Mydriatic (tropicamide phenylephrine 1.0%): 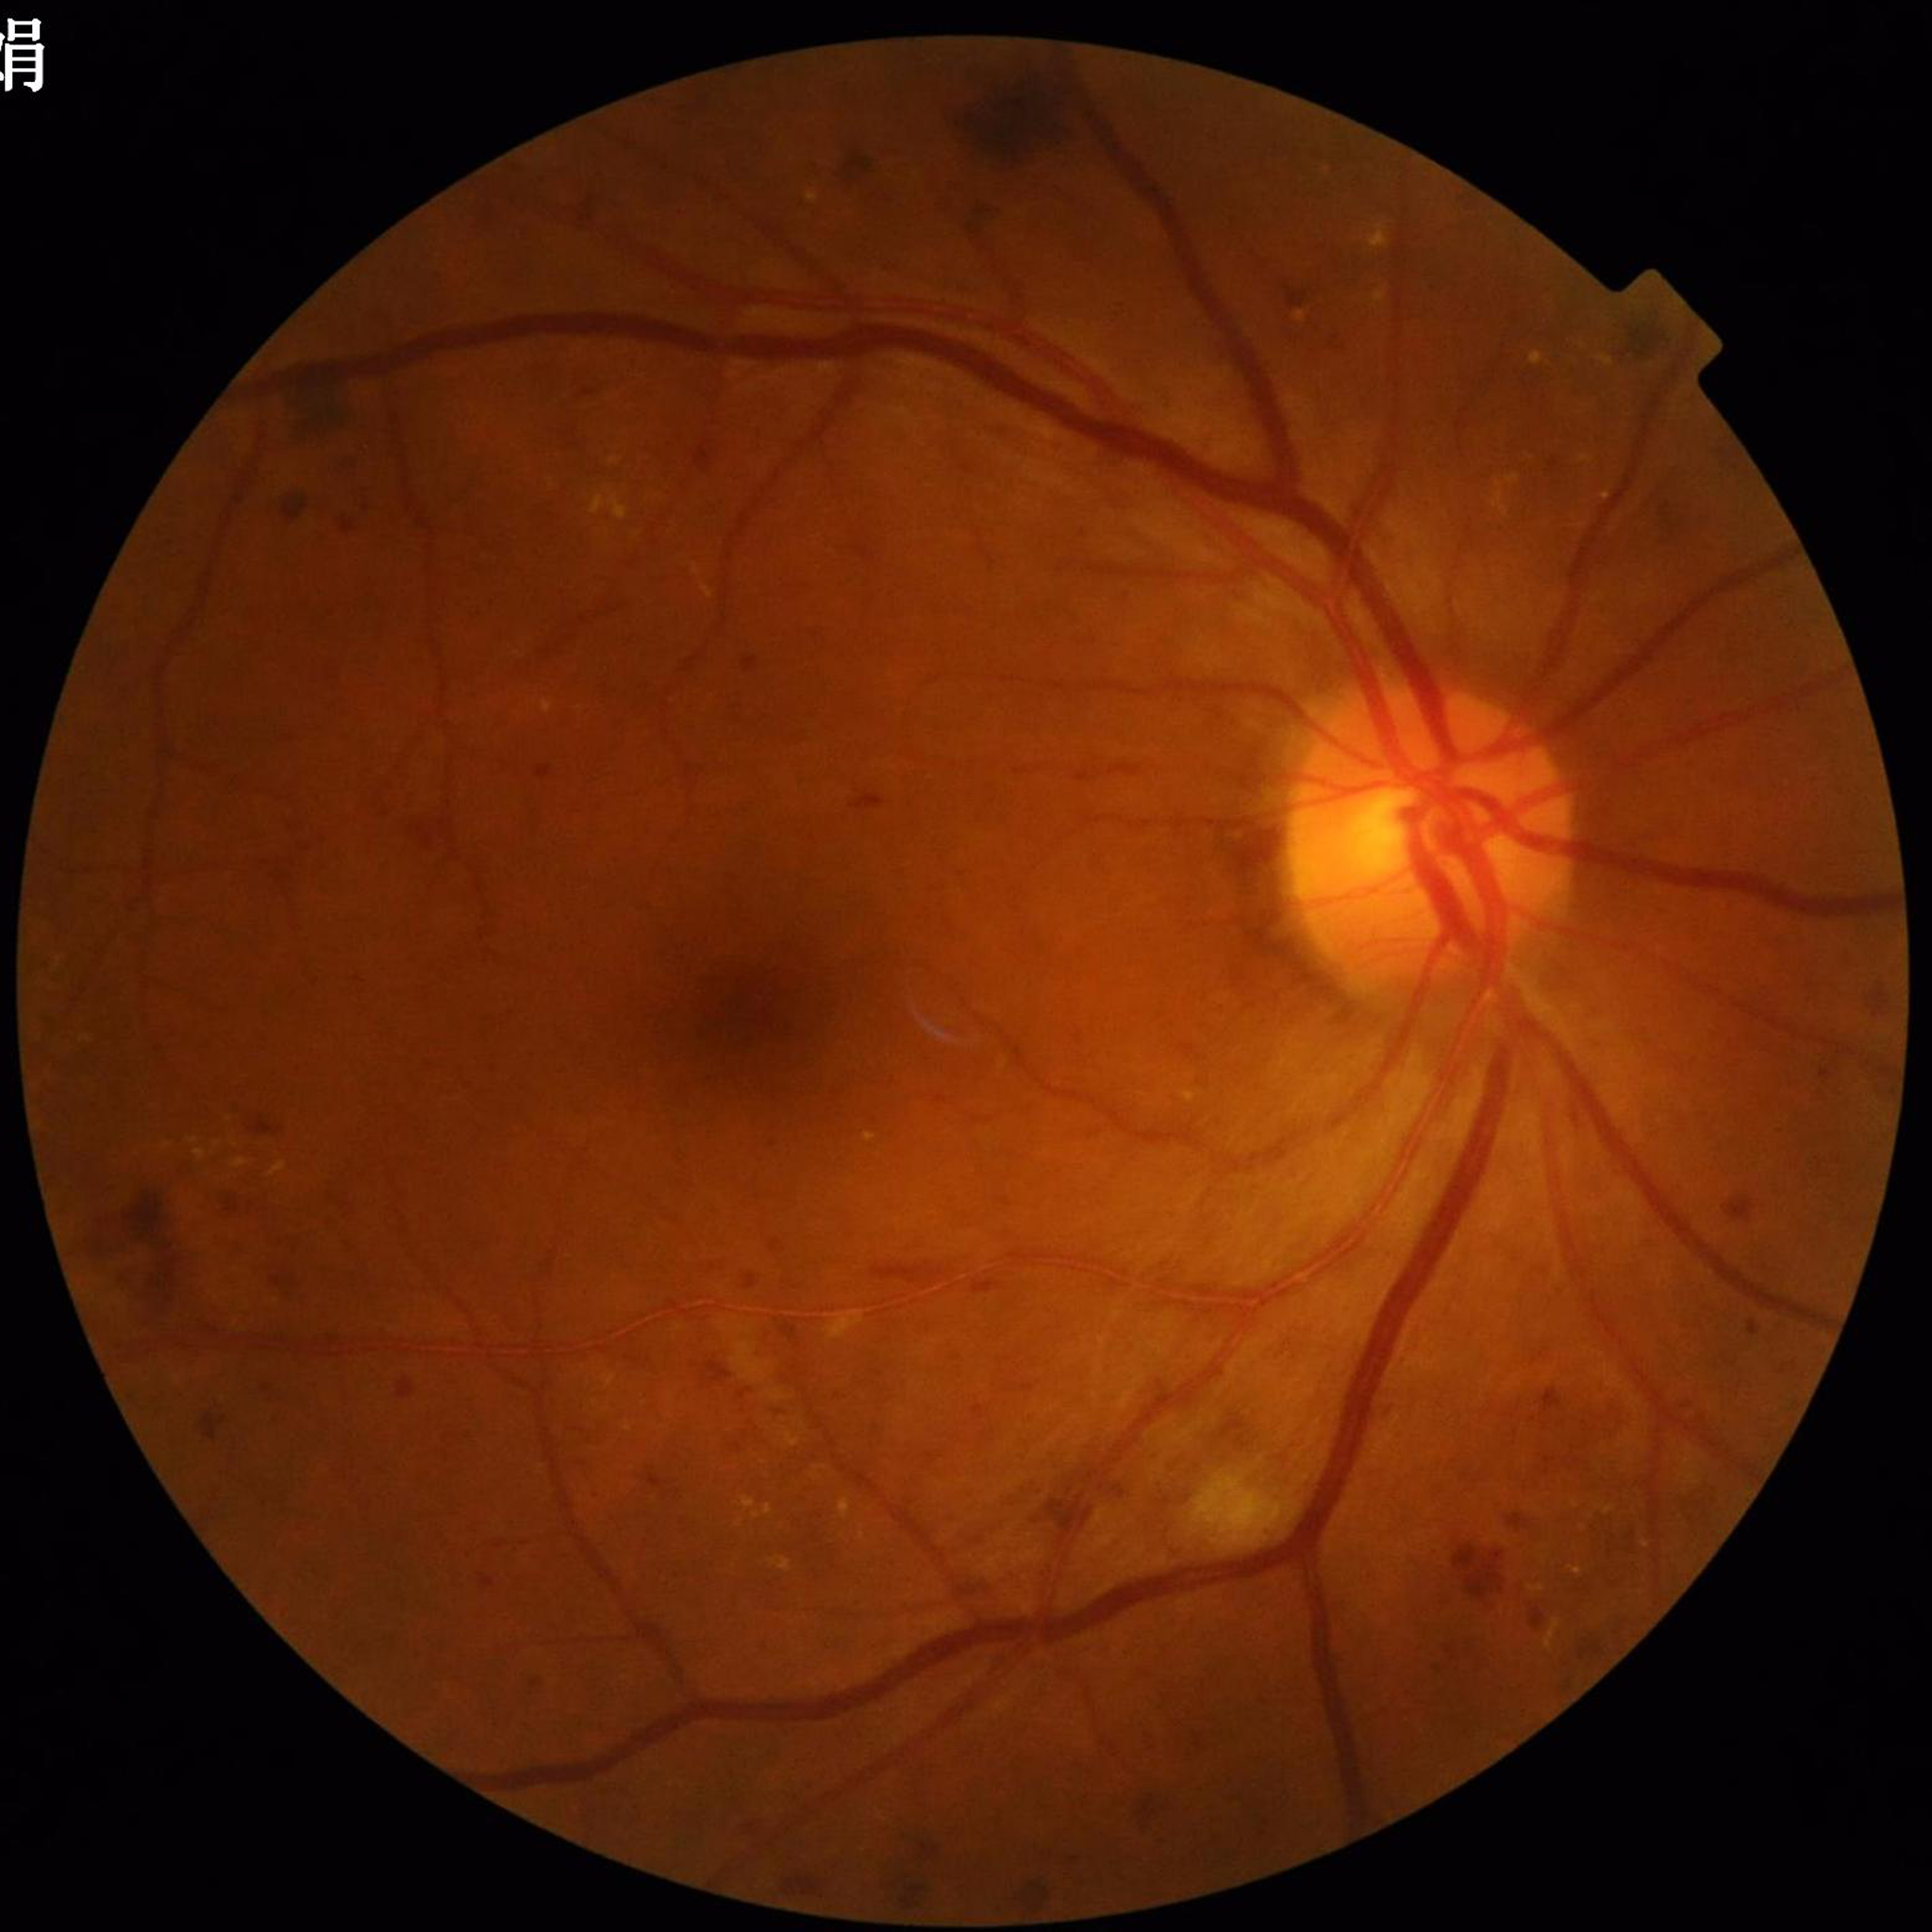

Color fundus photo. Patient diagnosed with diabetic retinopathy.